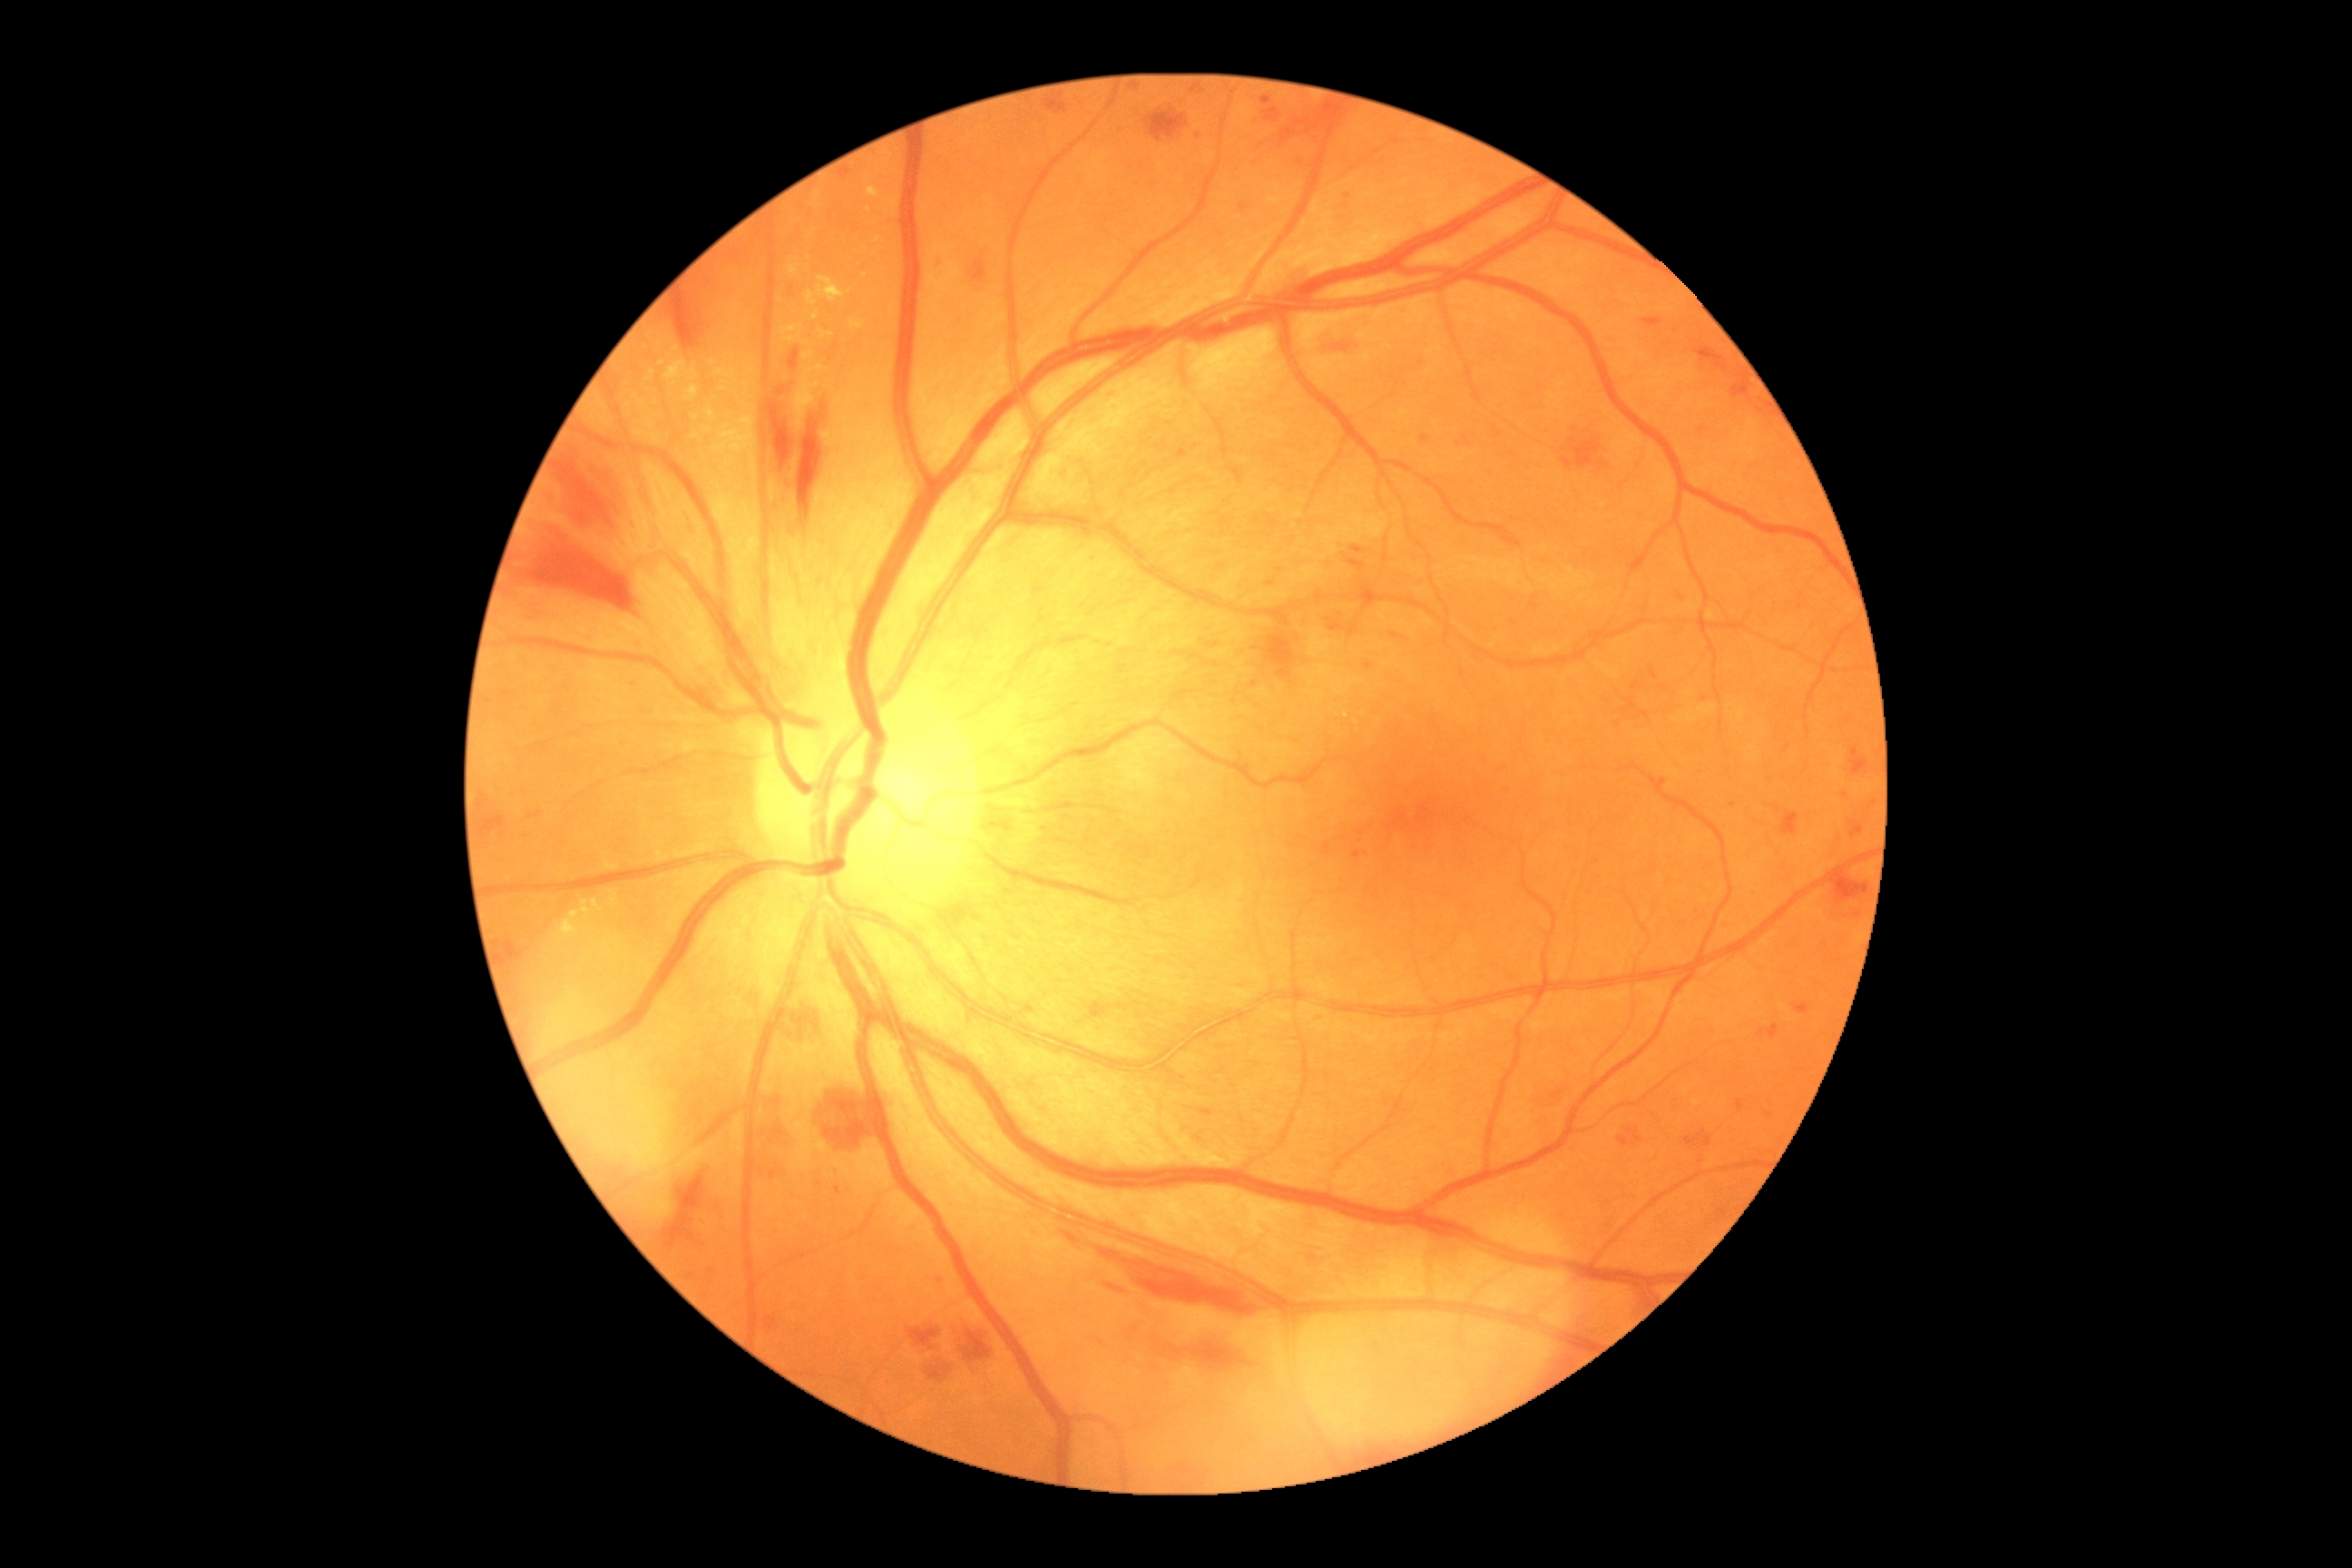
DR class = non-proliferative diabetic retinopathy; diabetic retinopathy grade = 2 — more than just microaneurysms but less than severe NPDR.